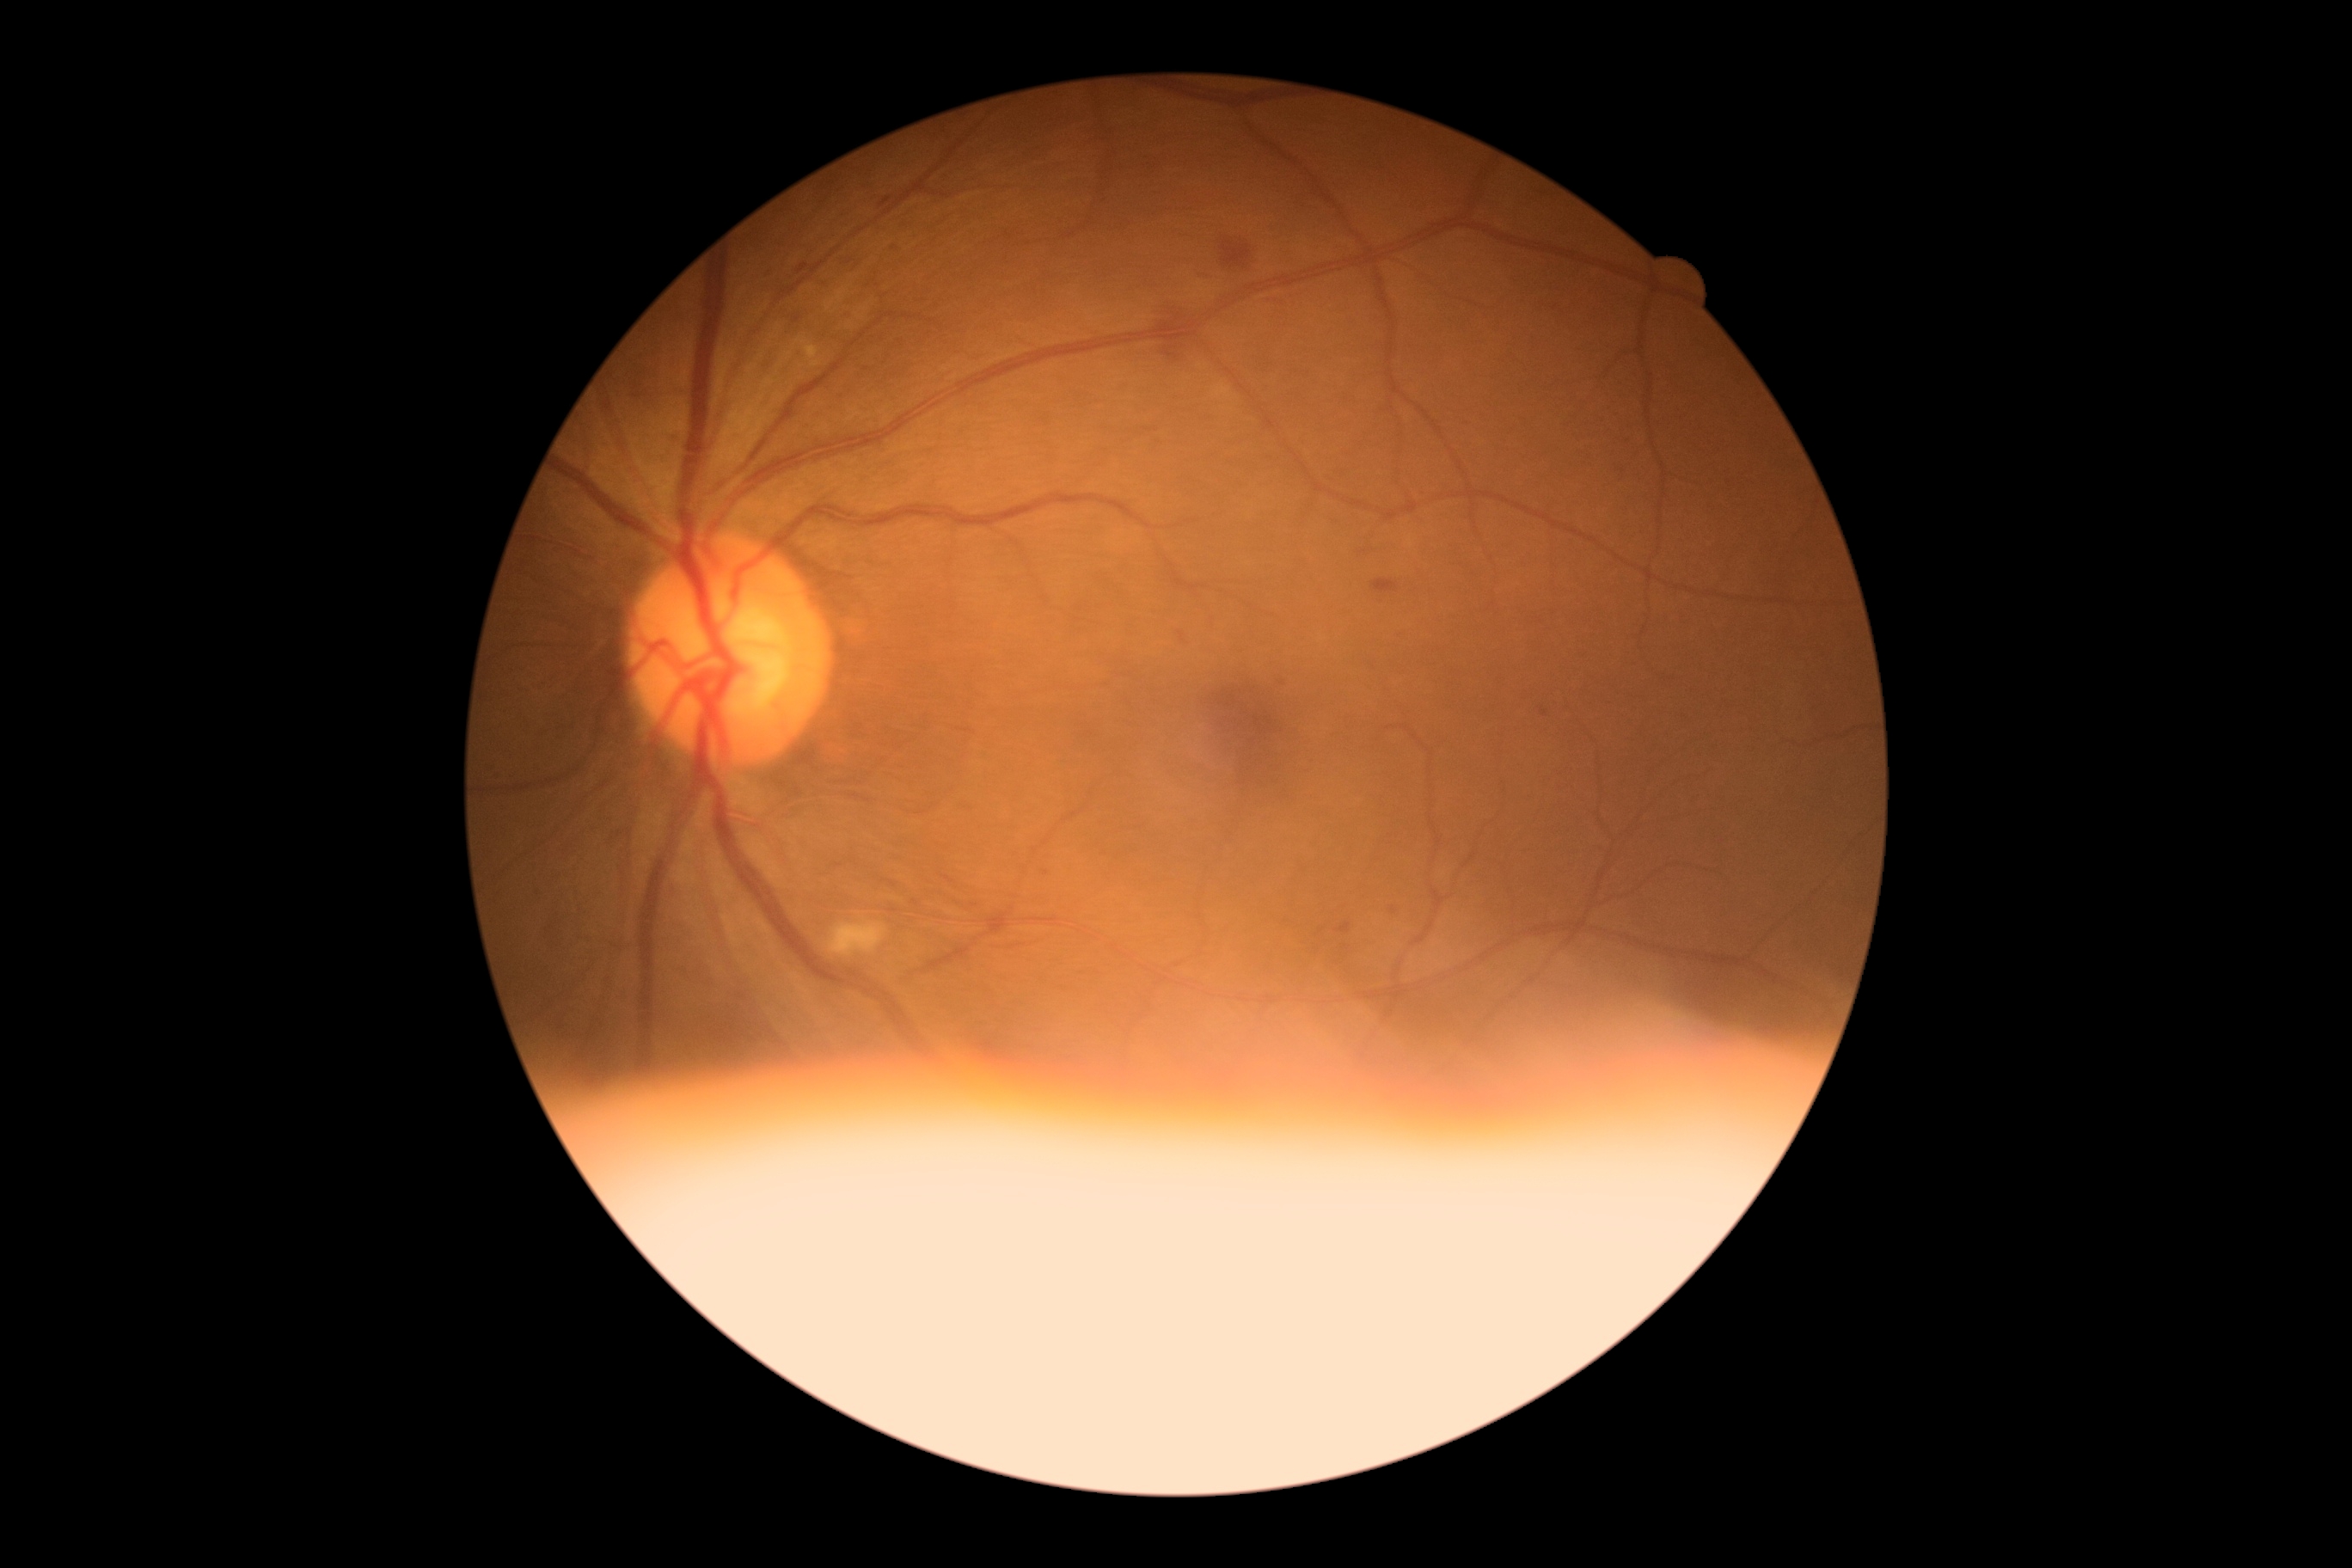 Diabetic retinopathy: grade 2 (moderate NPDR).